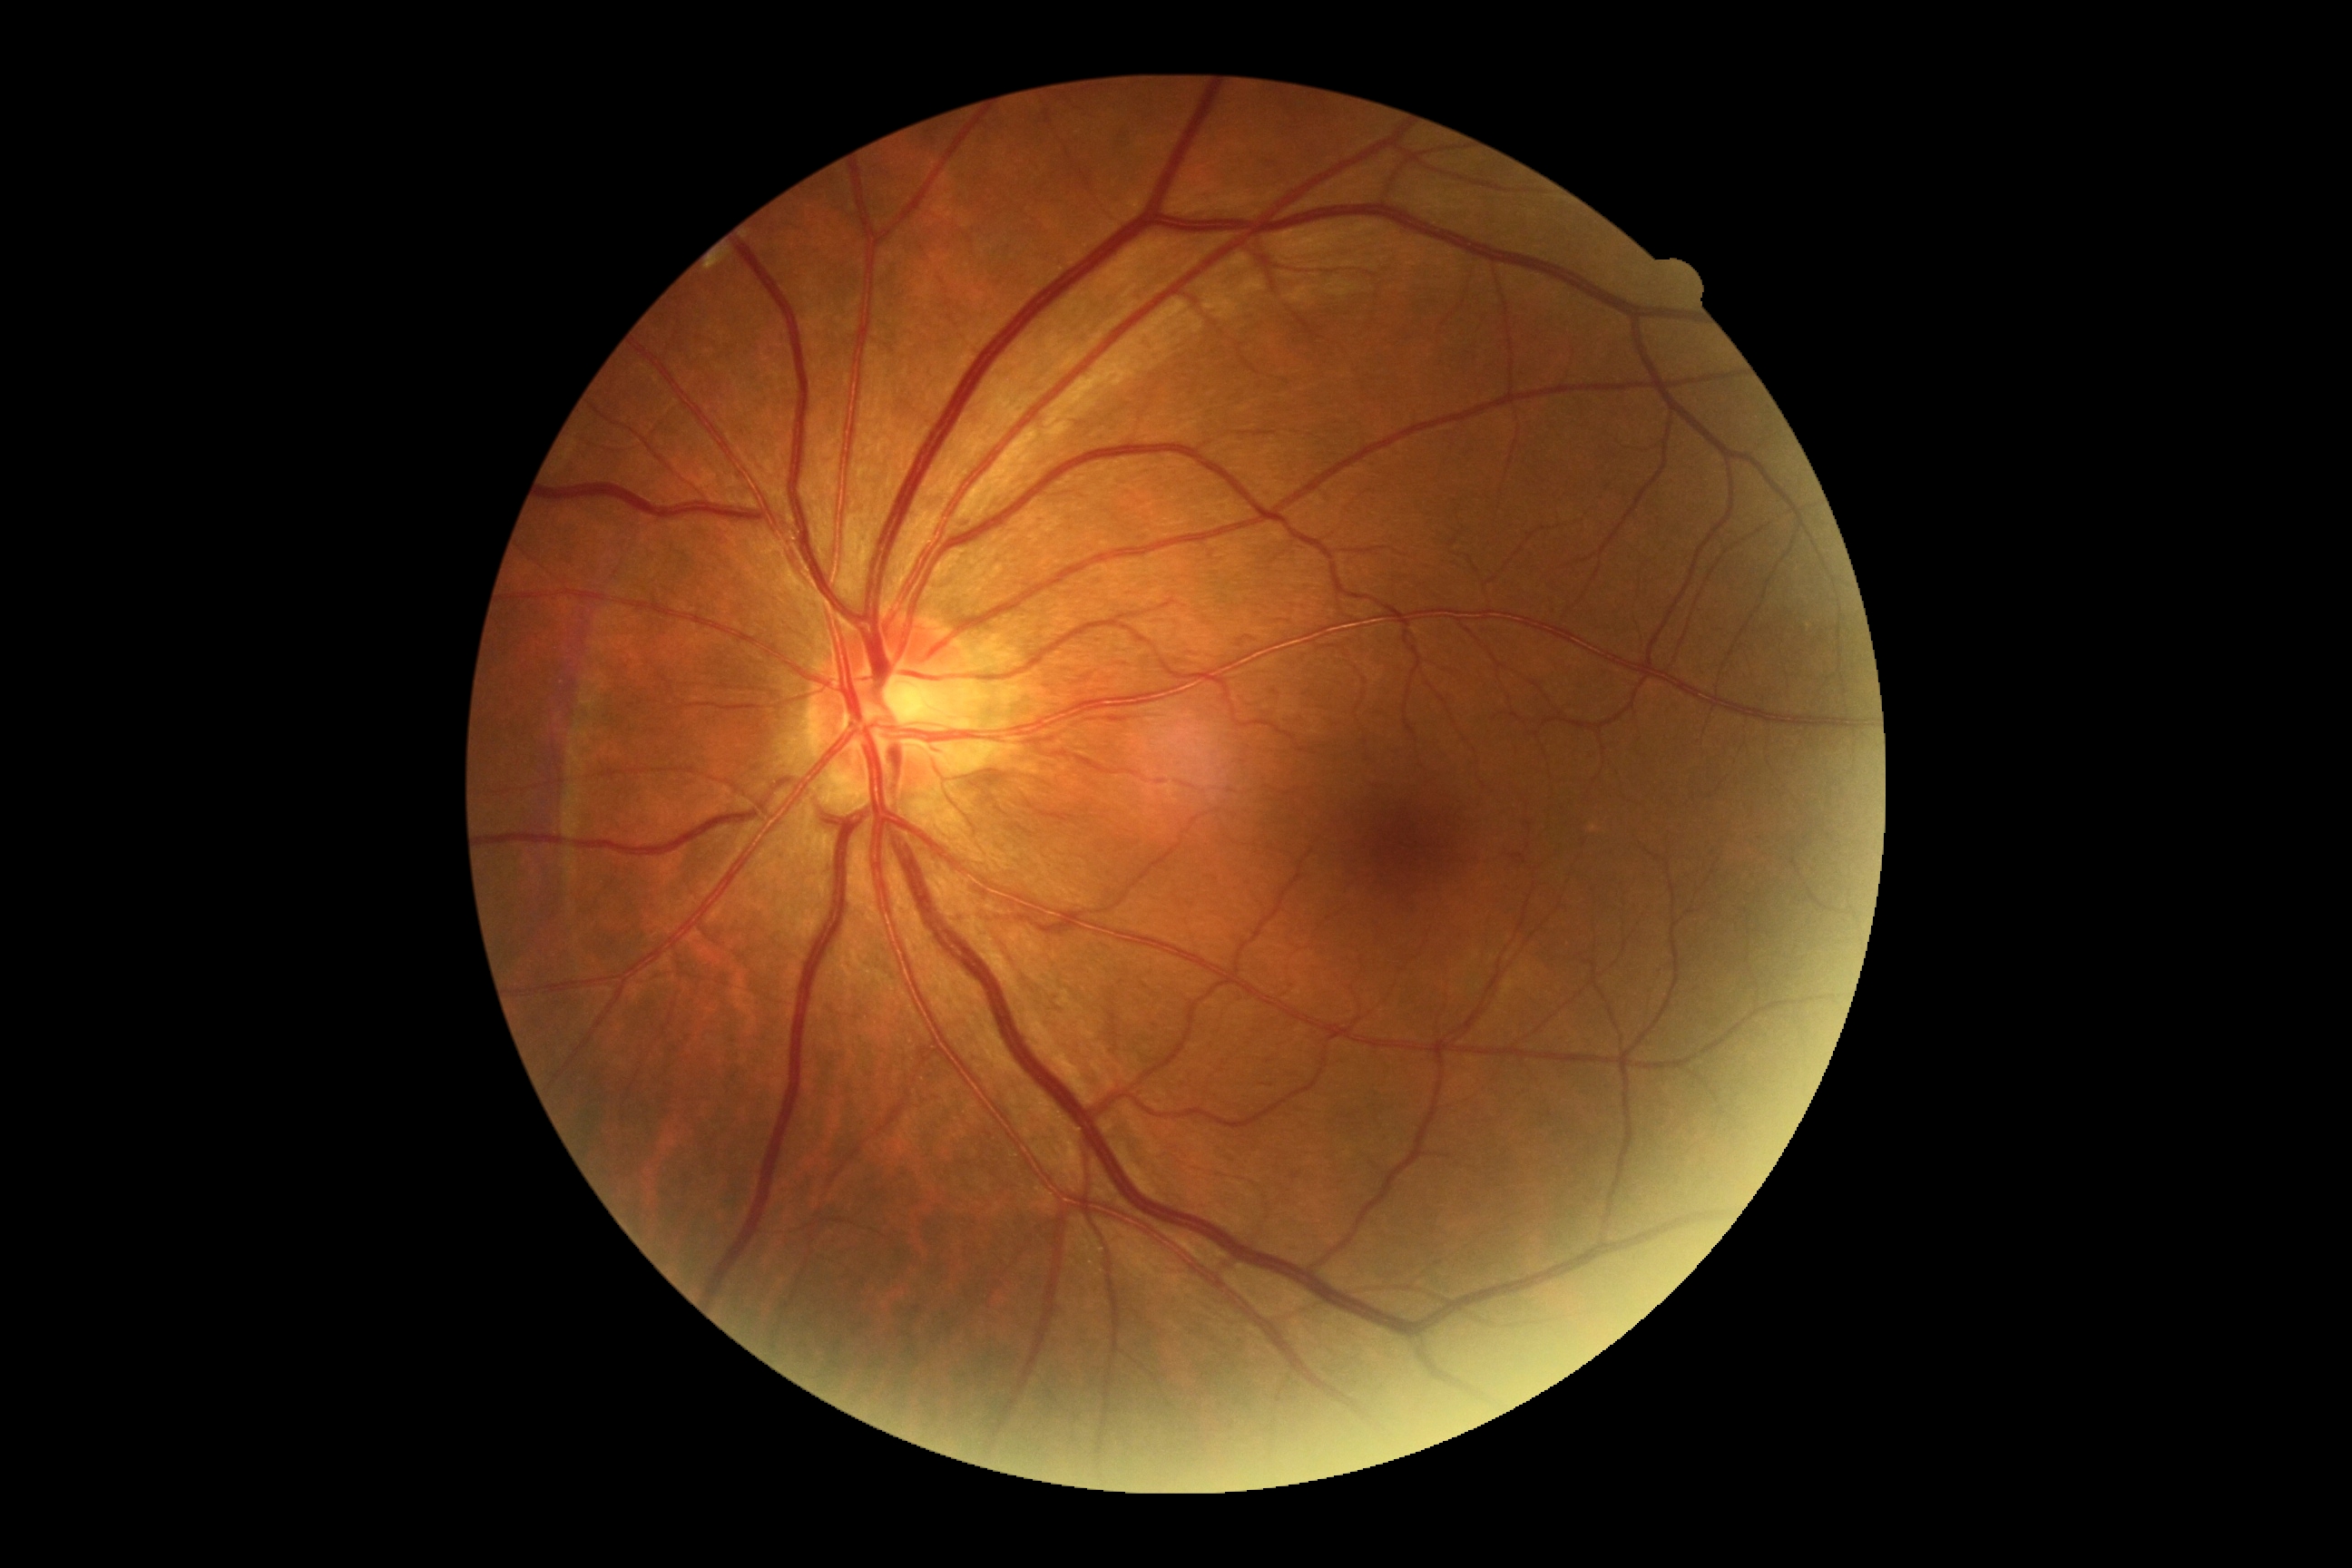

Diabetic retinopathy is grade 0.